45-degree field of view; without pupil dilation:
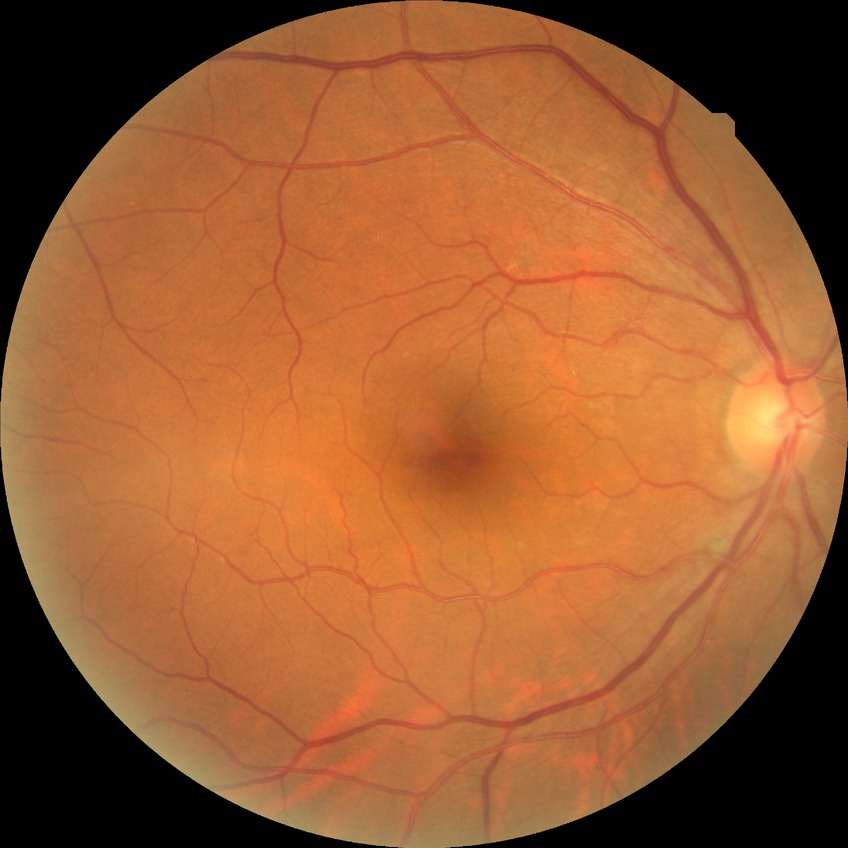
DR grade=NDR; DR impression=no apparent DR.